Image size 2352x1568. 45-degree field of view
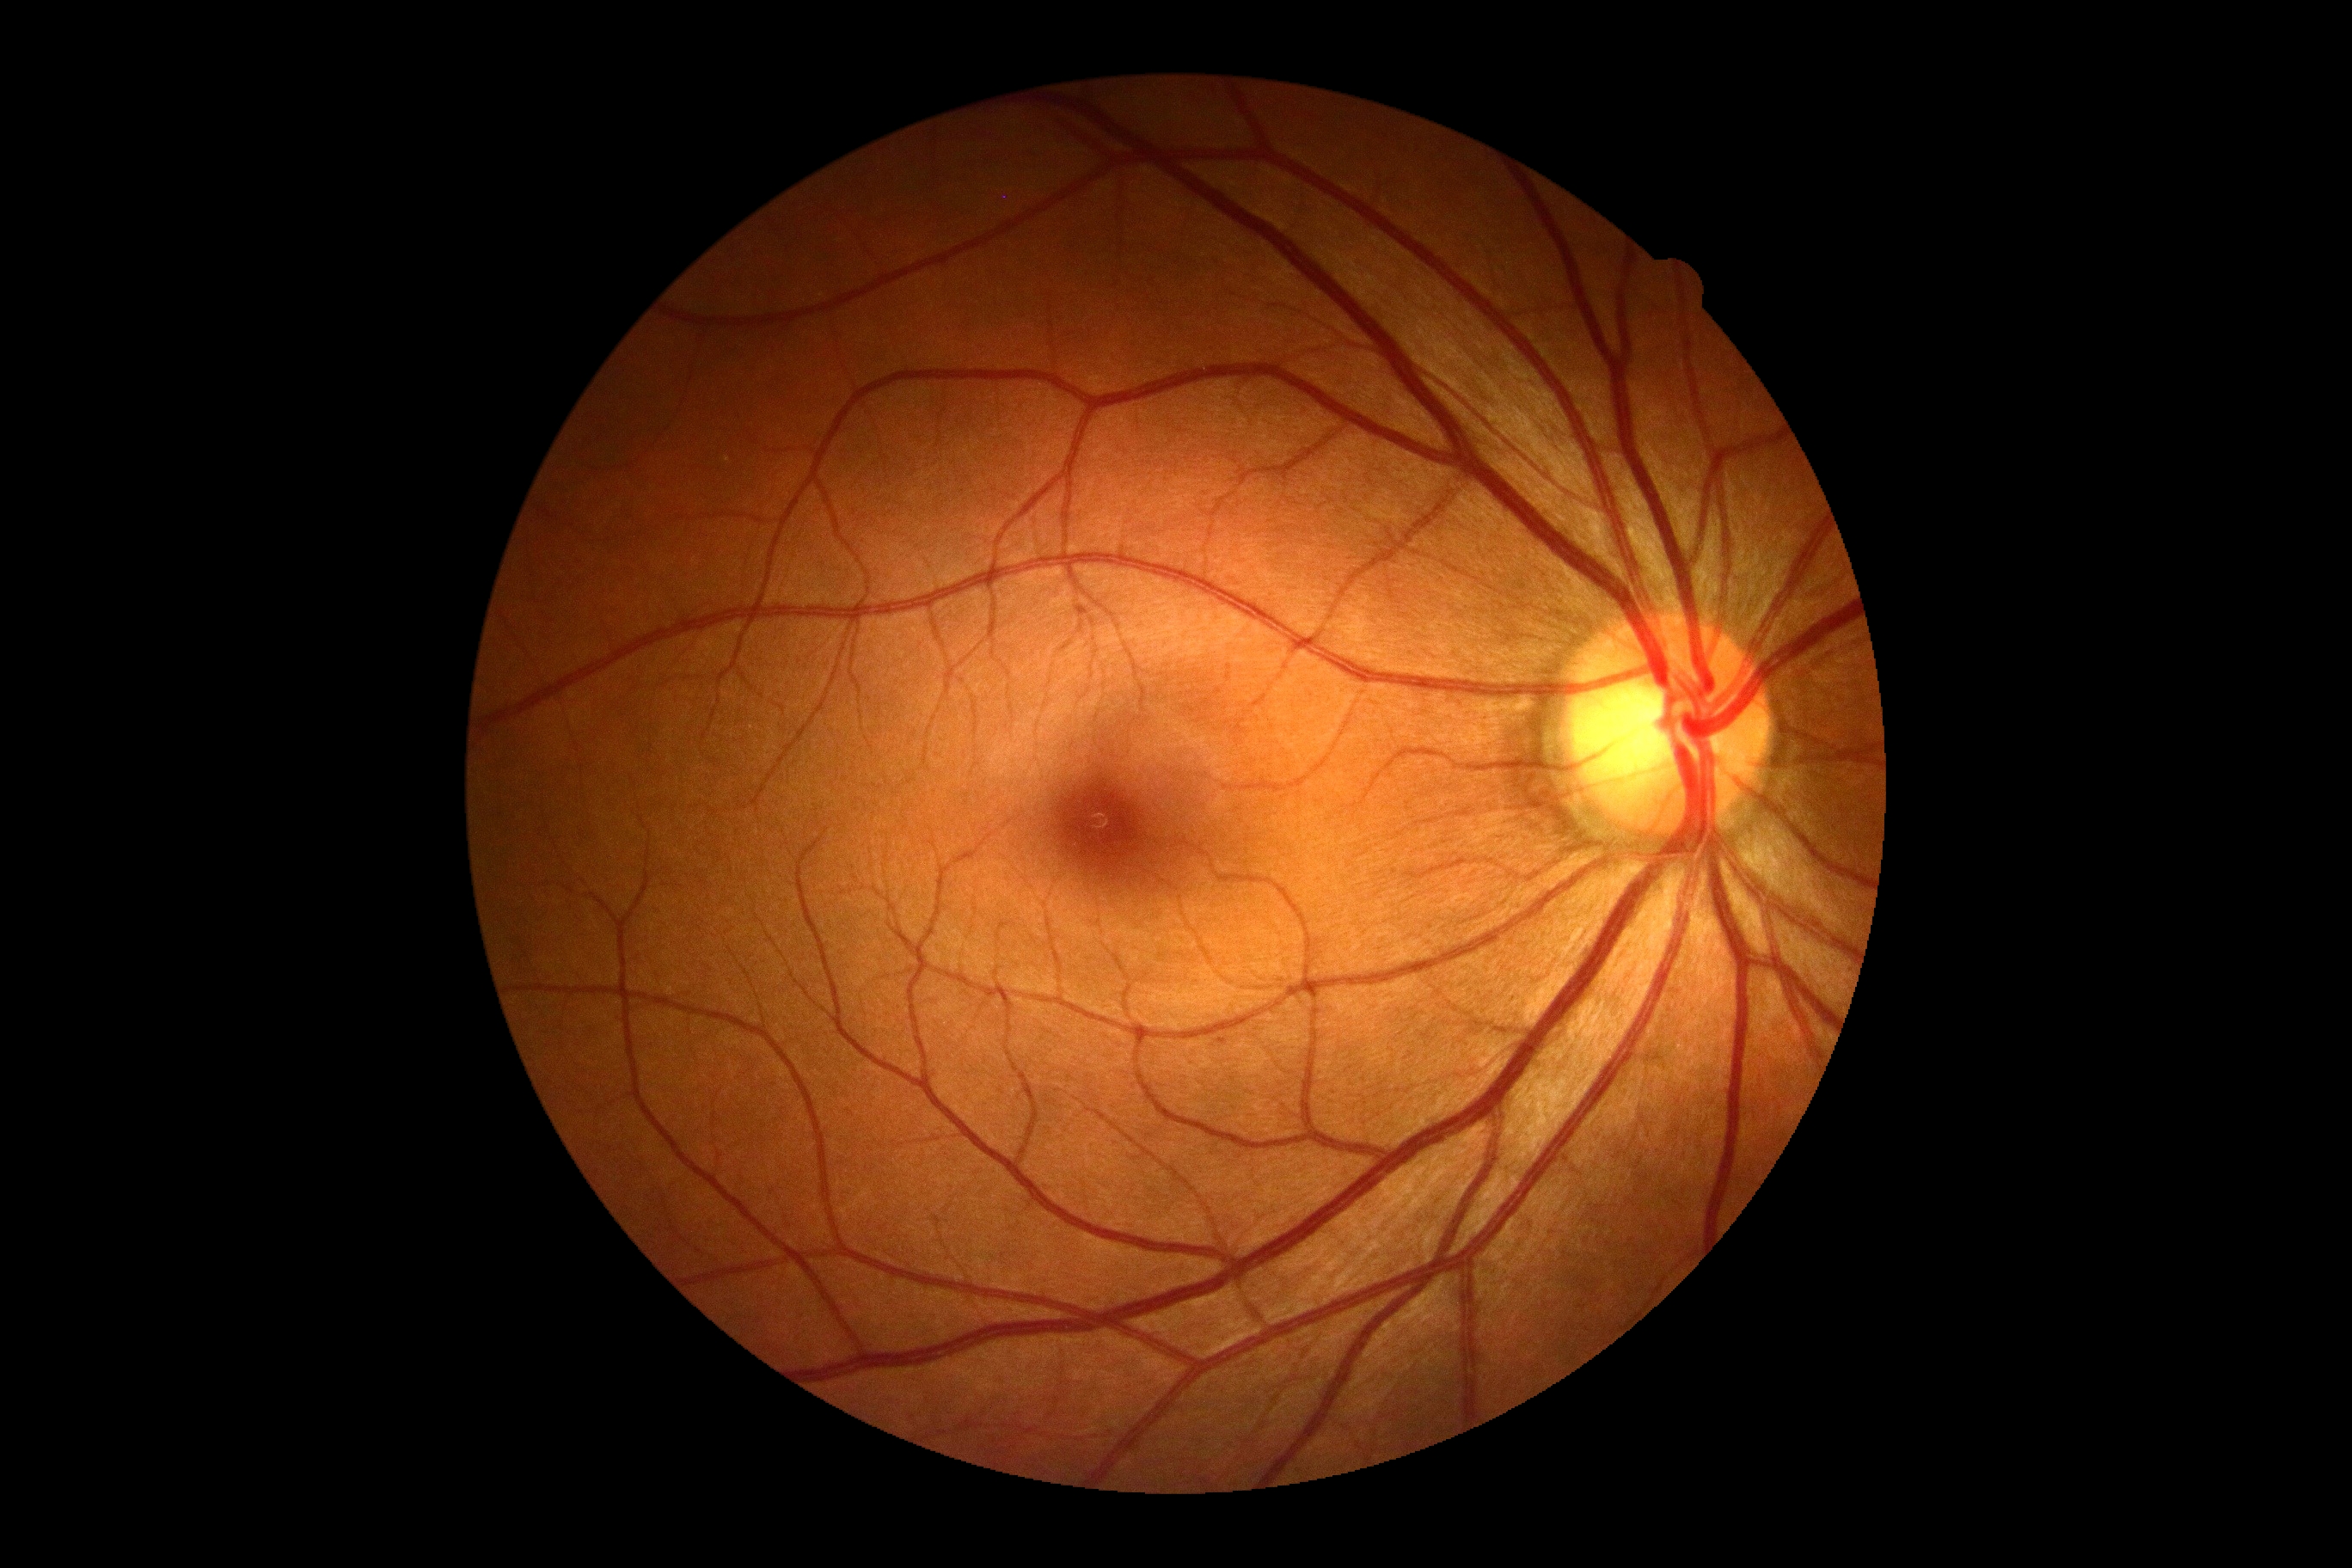 Diabetic retinopathy (DR): grade 0.
No apparent diabetic retinopathy.